2352 by 1568 pixels.
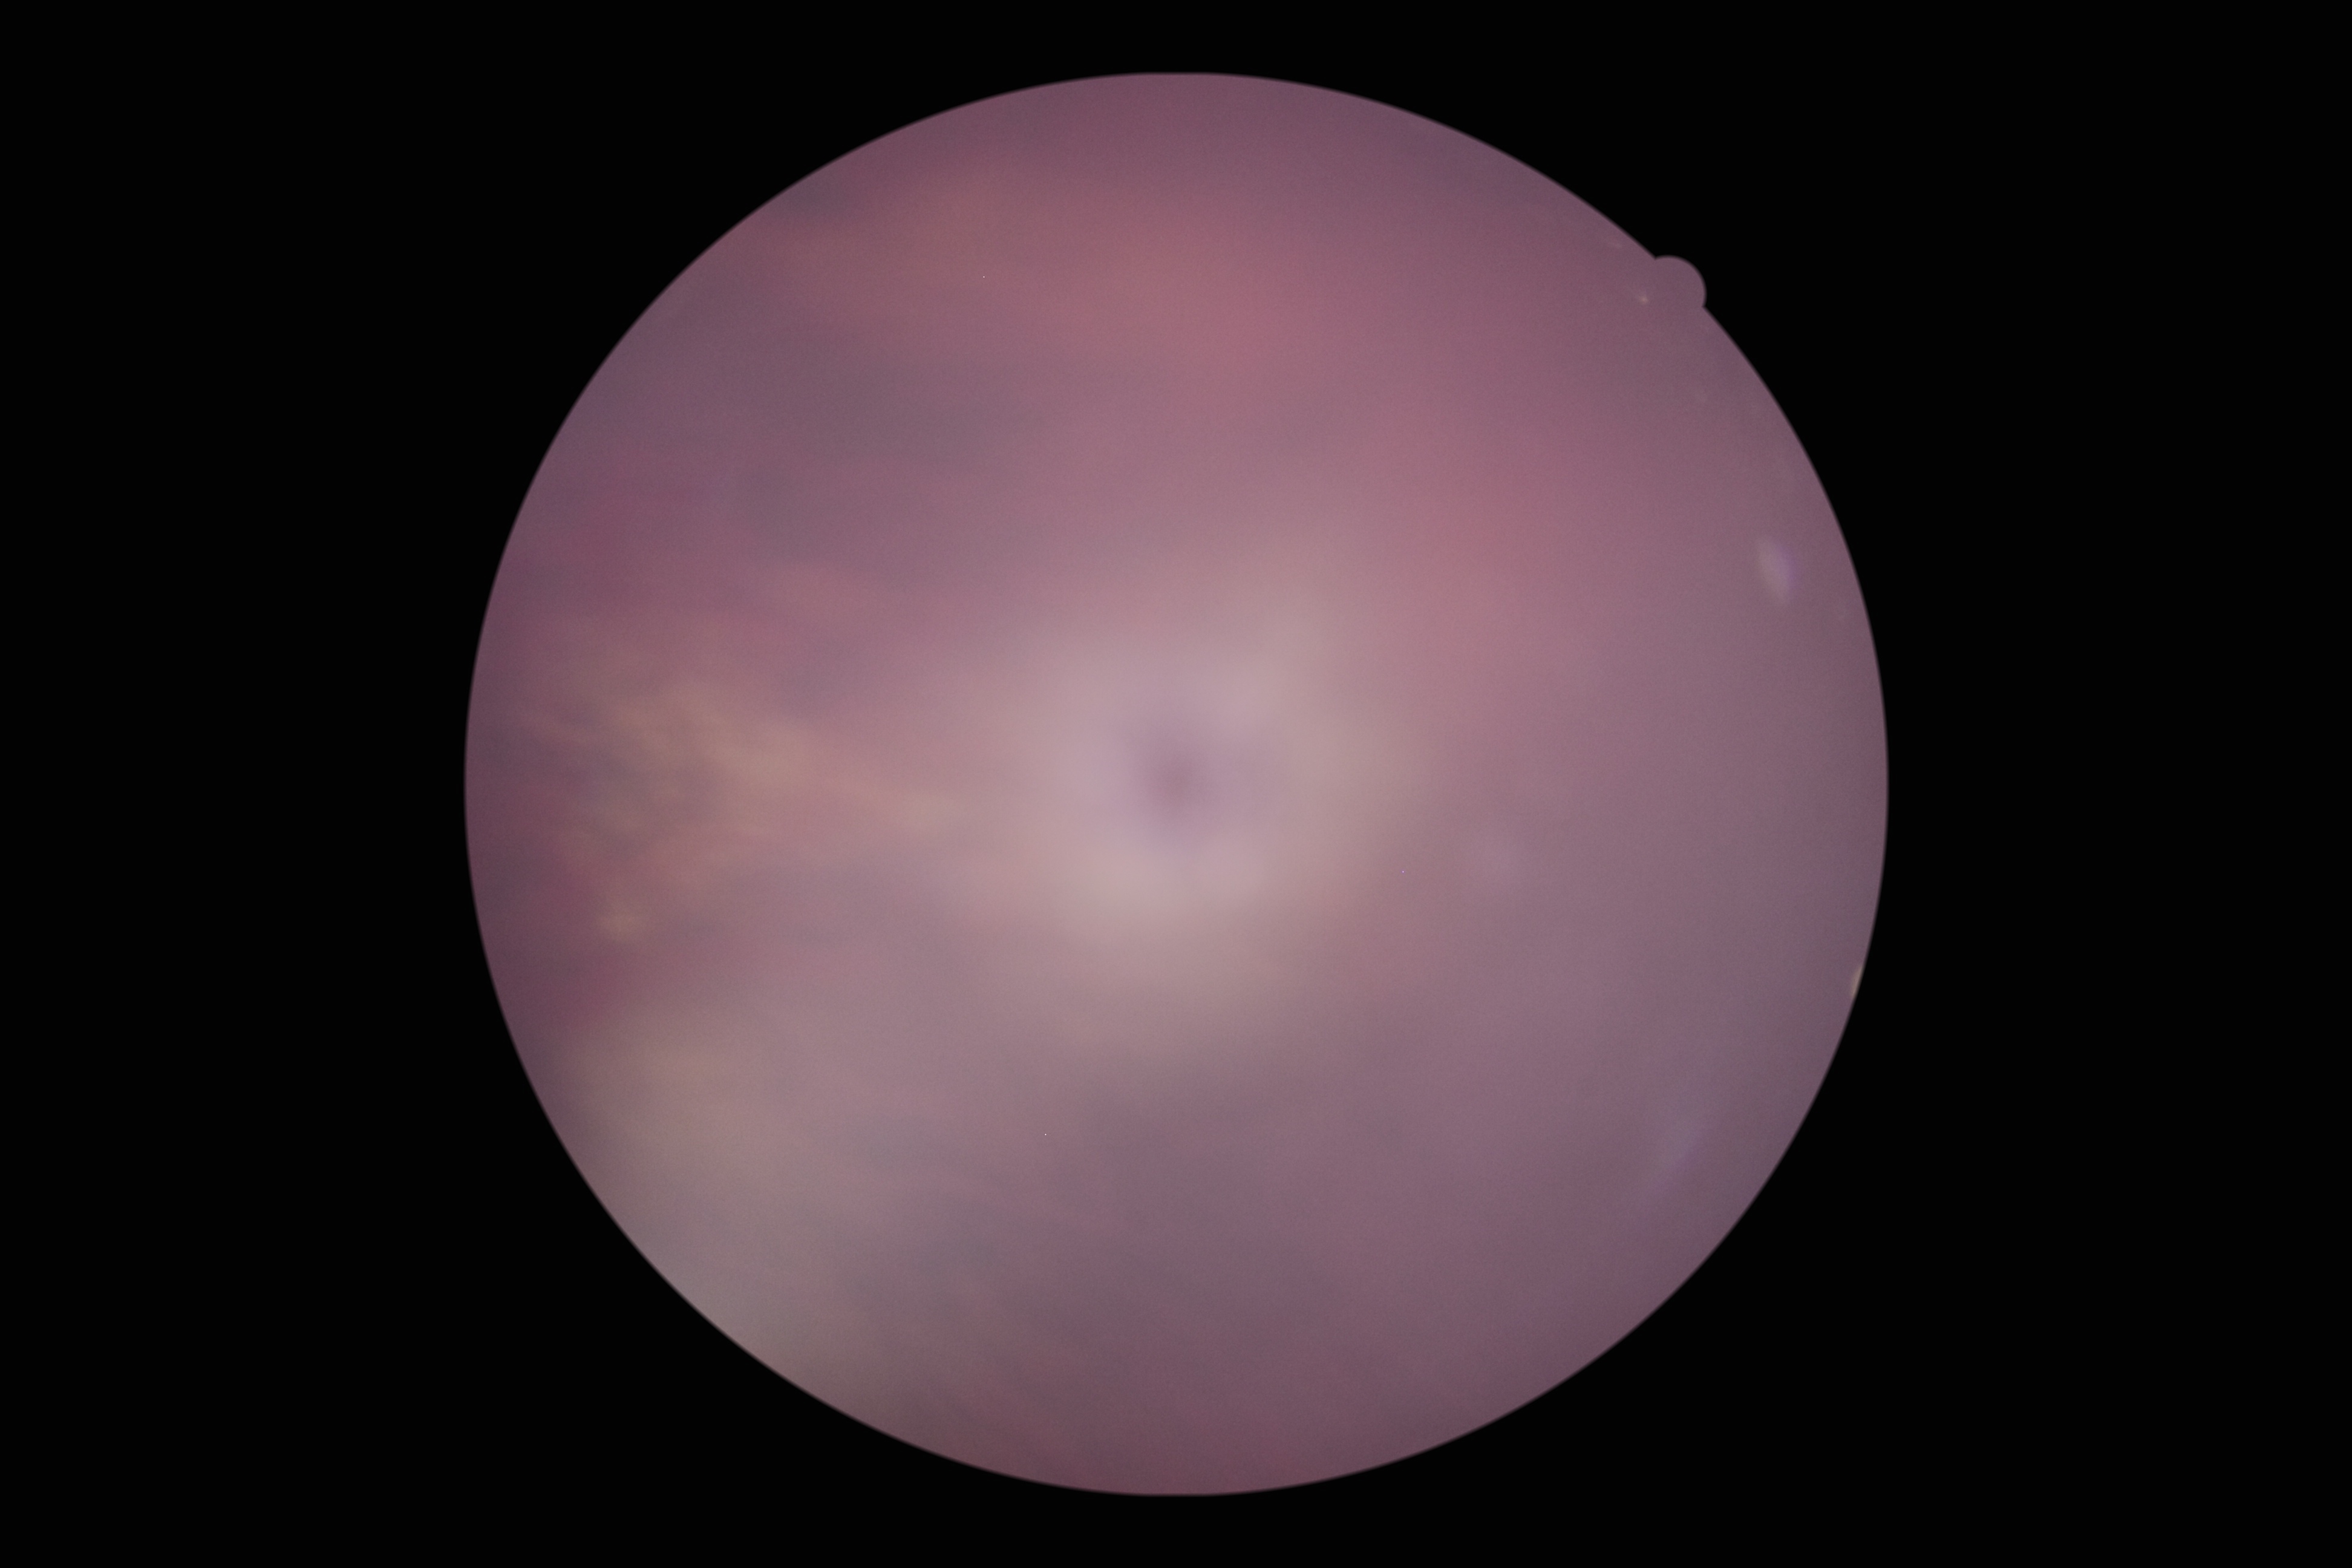 Ungradable image — DR severity cannot be determined. DR stage: ungradable due to poor image quality.